1240 x 1240 pixels · infant wide-field retinal image · acquired on the Phoenix ICON
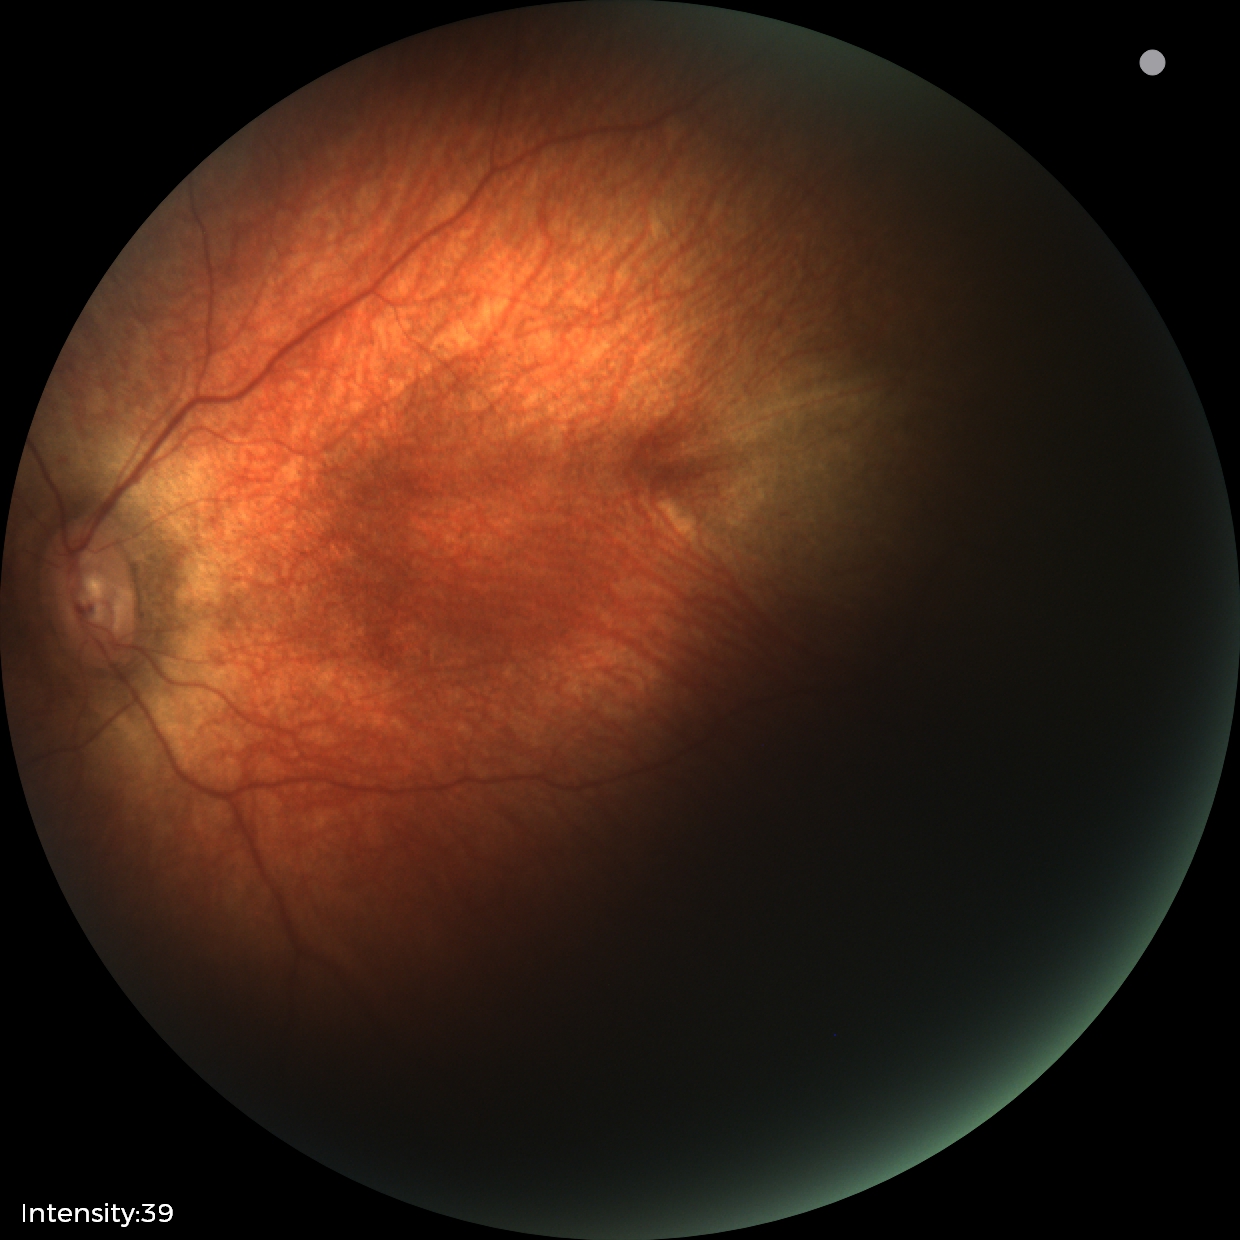
Screening diagnosis: physiological appearance.